CFP:
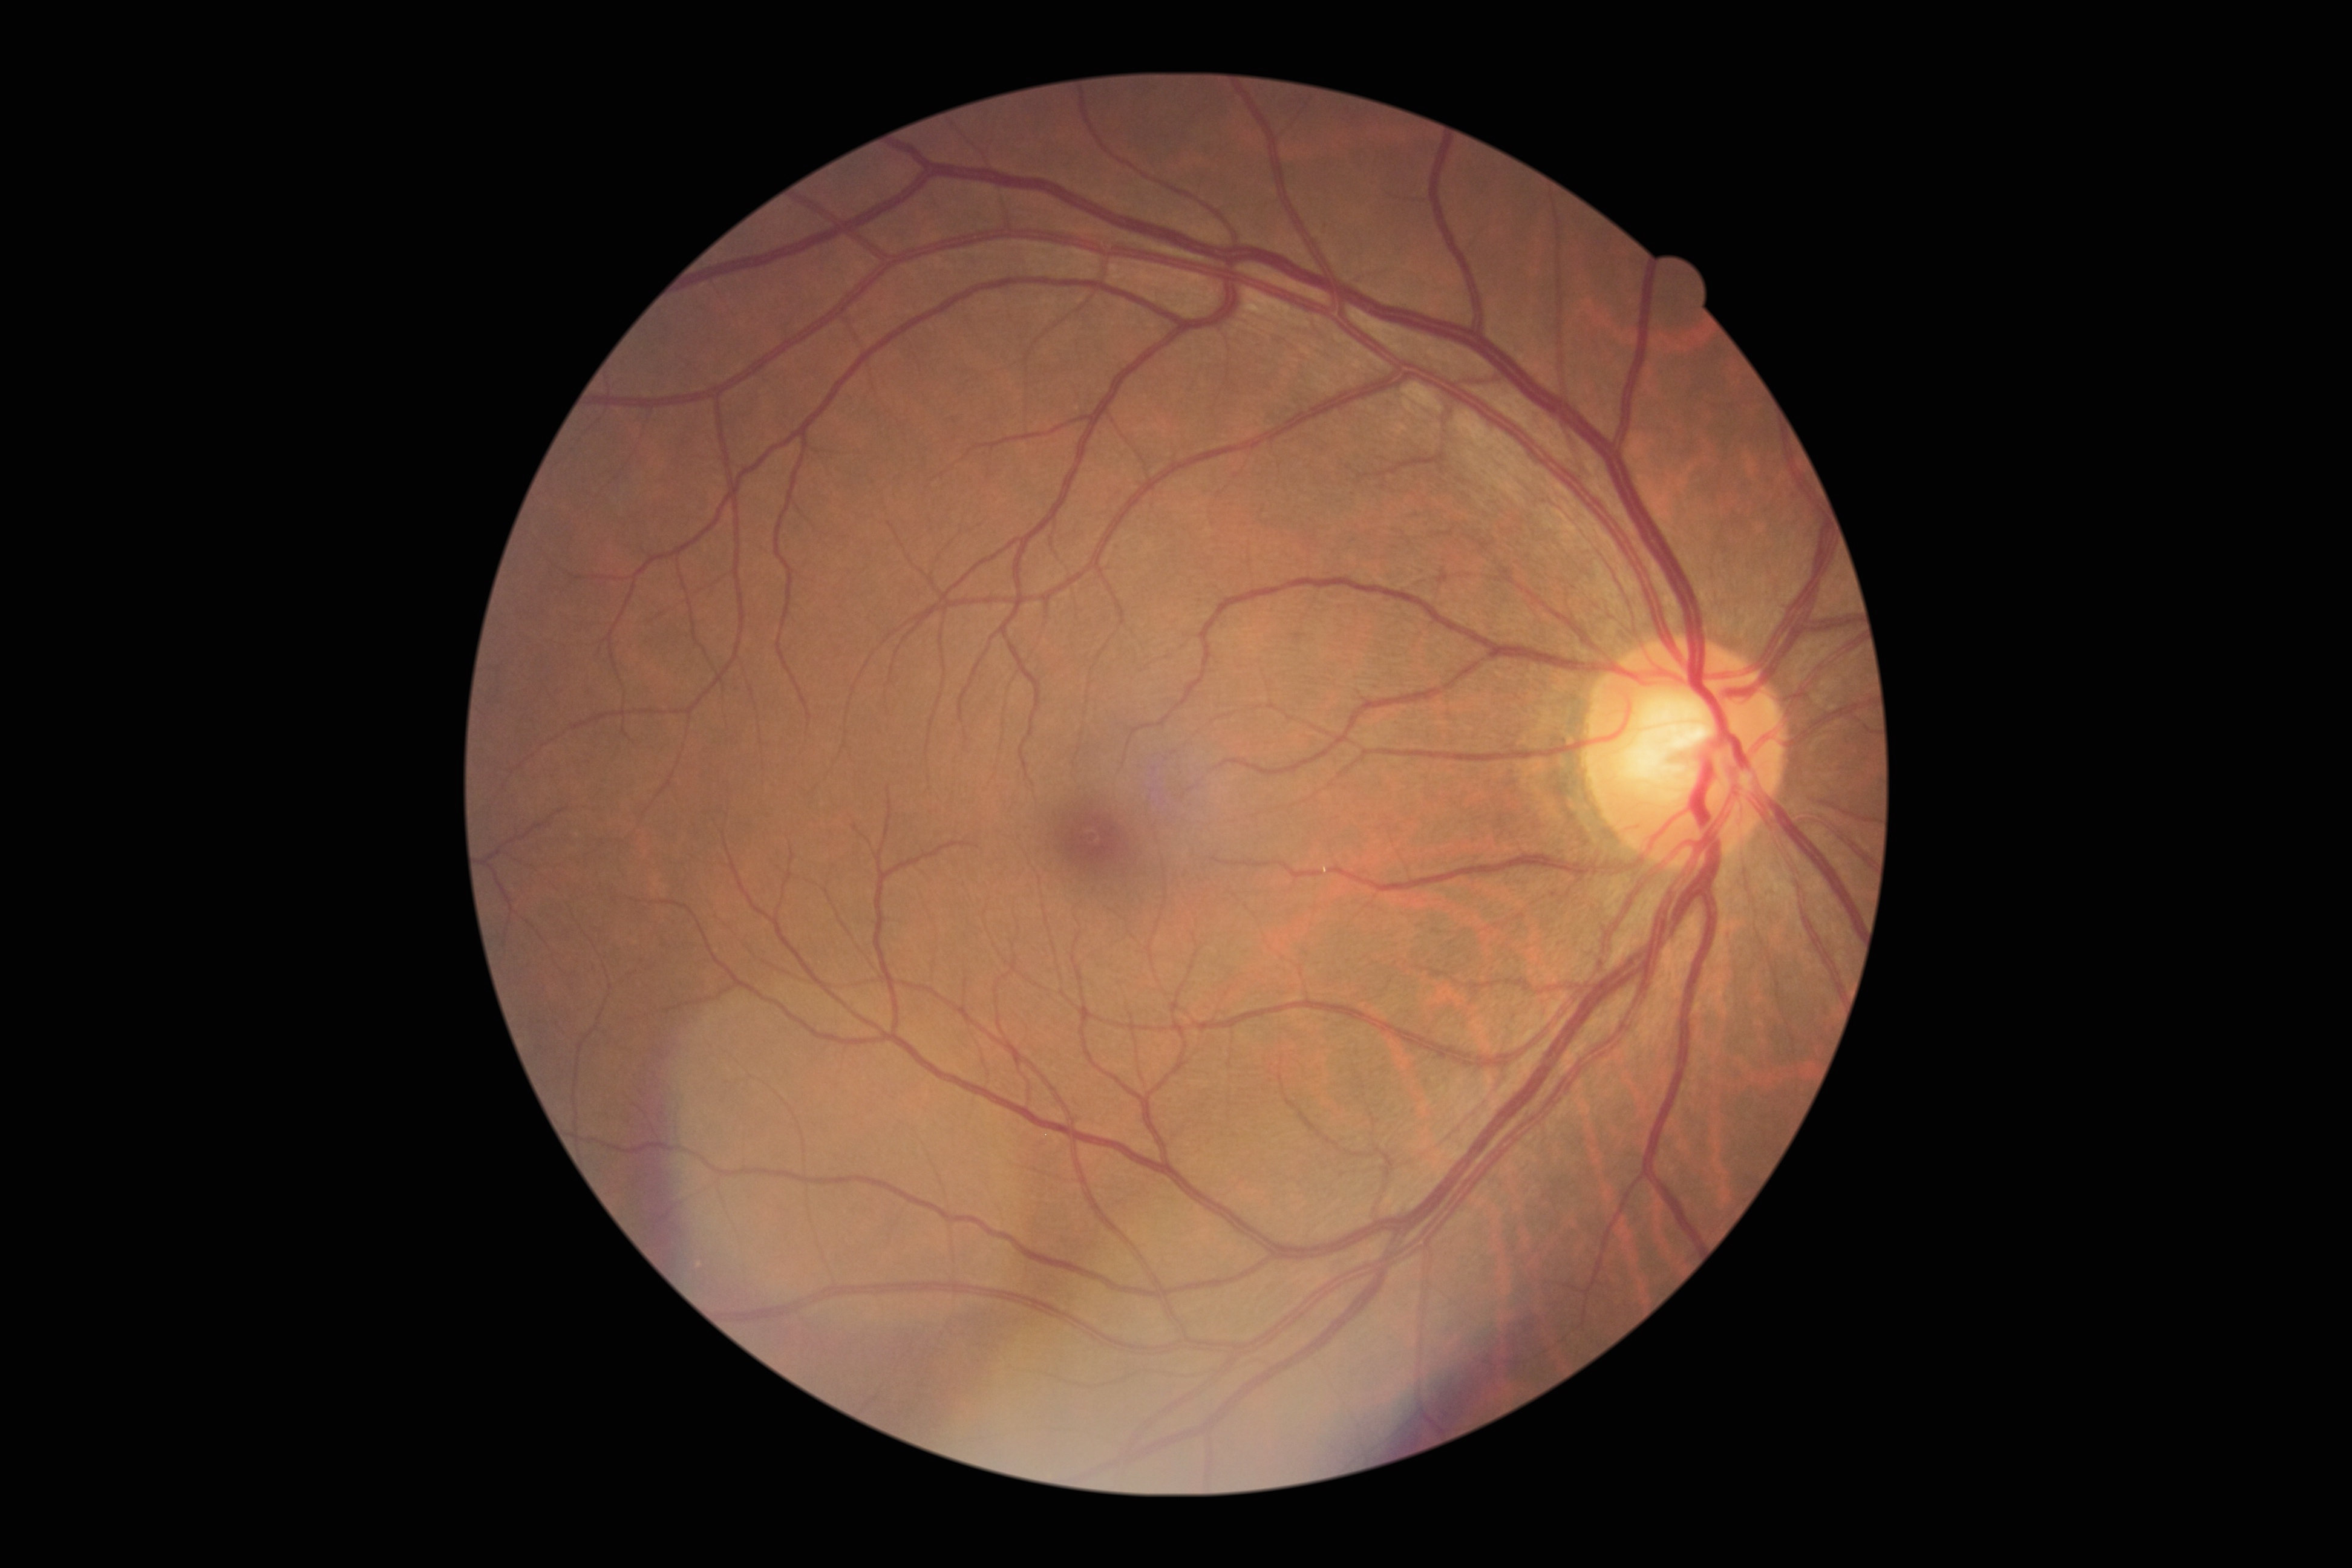
Retinopathy is grade 0.